Non-mydriatic fundus camera — 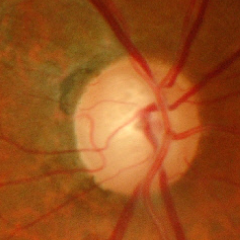
Fundus image with findings of severe glaucomatous damage.